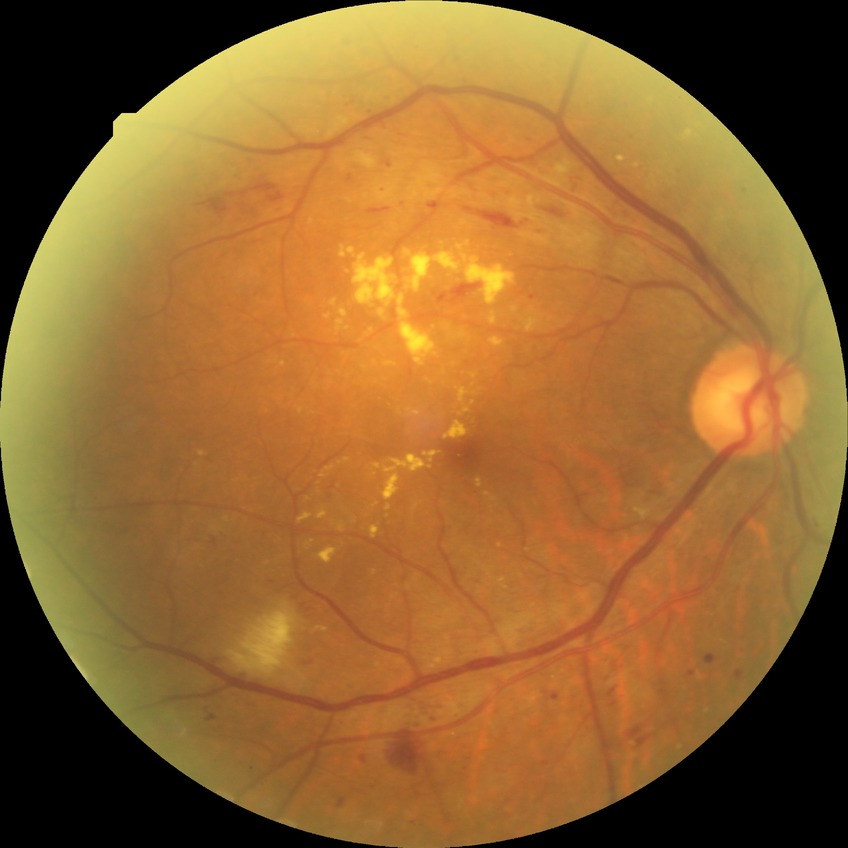

davis_grade: PDR (proliferative diabetic retinopathy)